Infant wide-field retinal image · image size 640x480 · Clarity RetCam 3, 130° FOV — 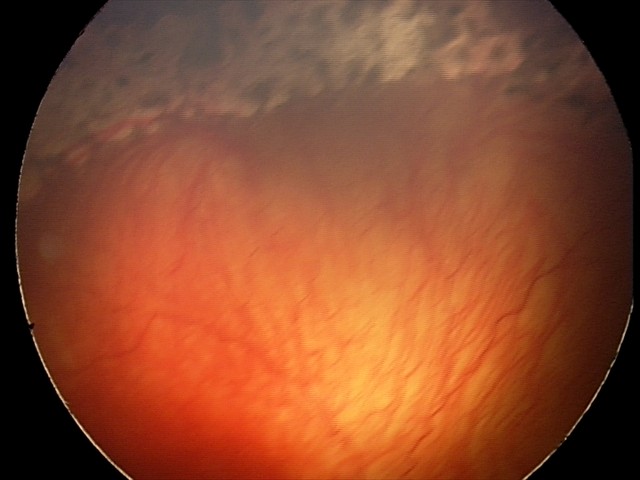 Screening examination consistent with aggressive retinopathy of prematurity.